Wide-field fundus photograph from neonatal ROP screening. 100° field of view (Phoenix ICON). Image size 1240x1240
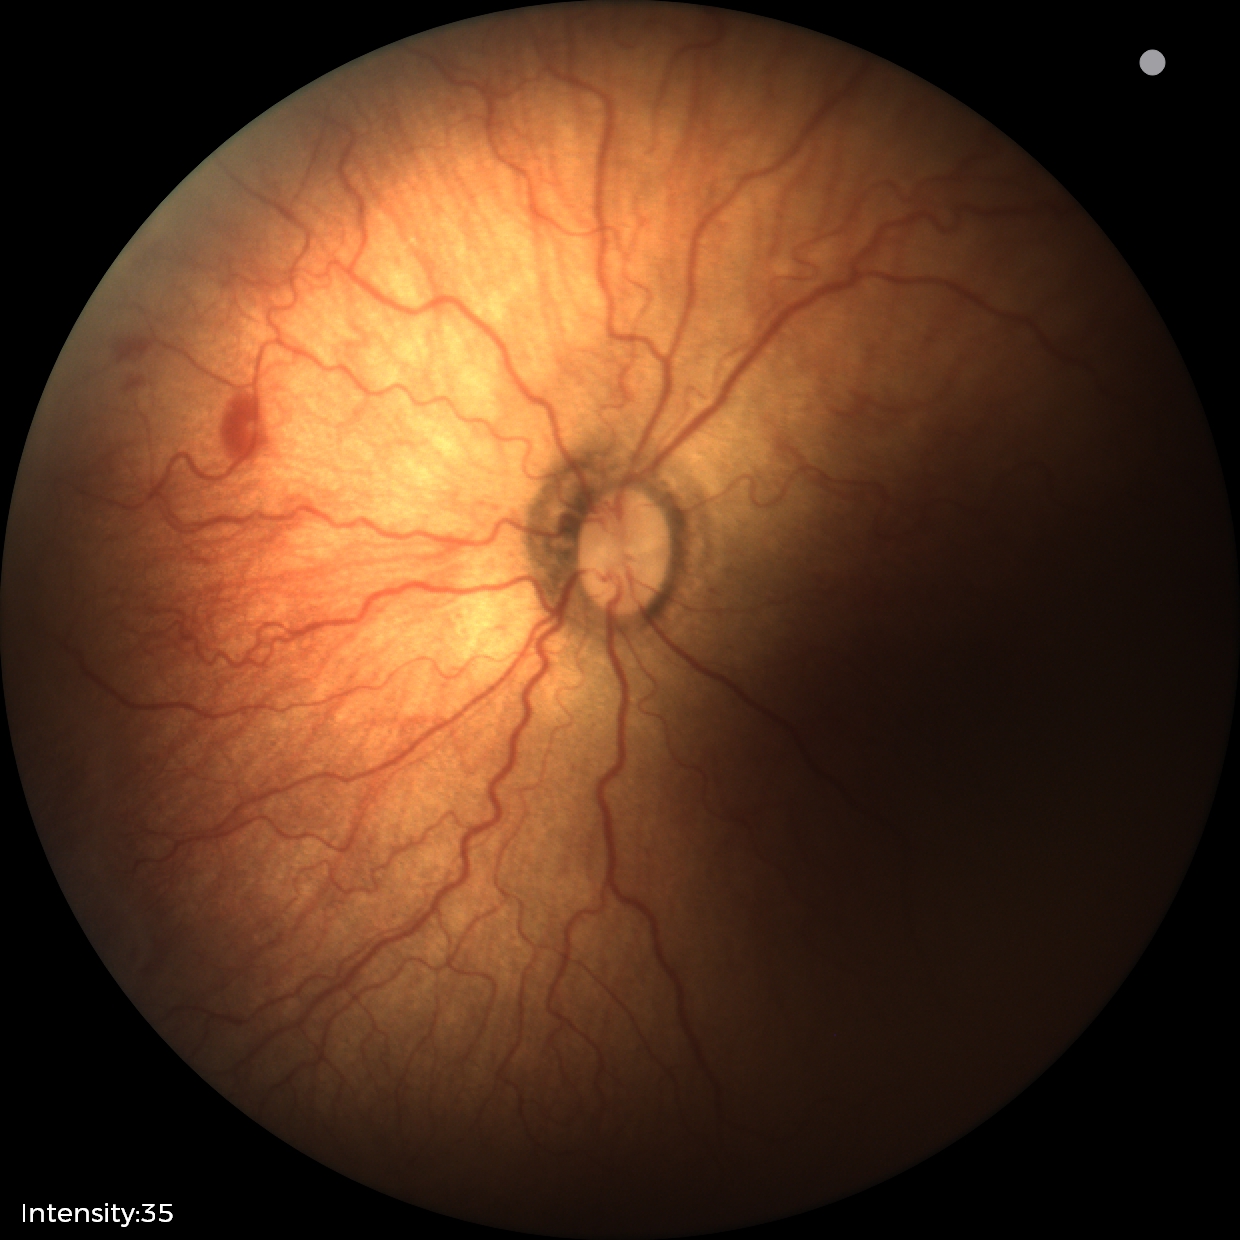

Screening examination consistent with ROP stage 2. Plus disease was diagnosed.